CFP: 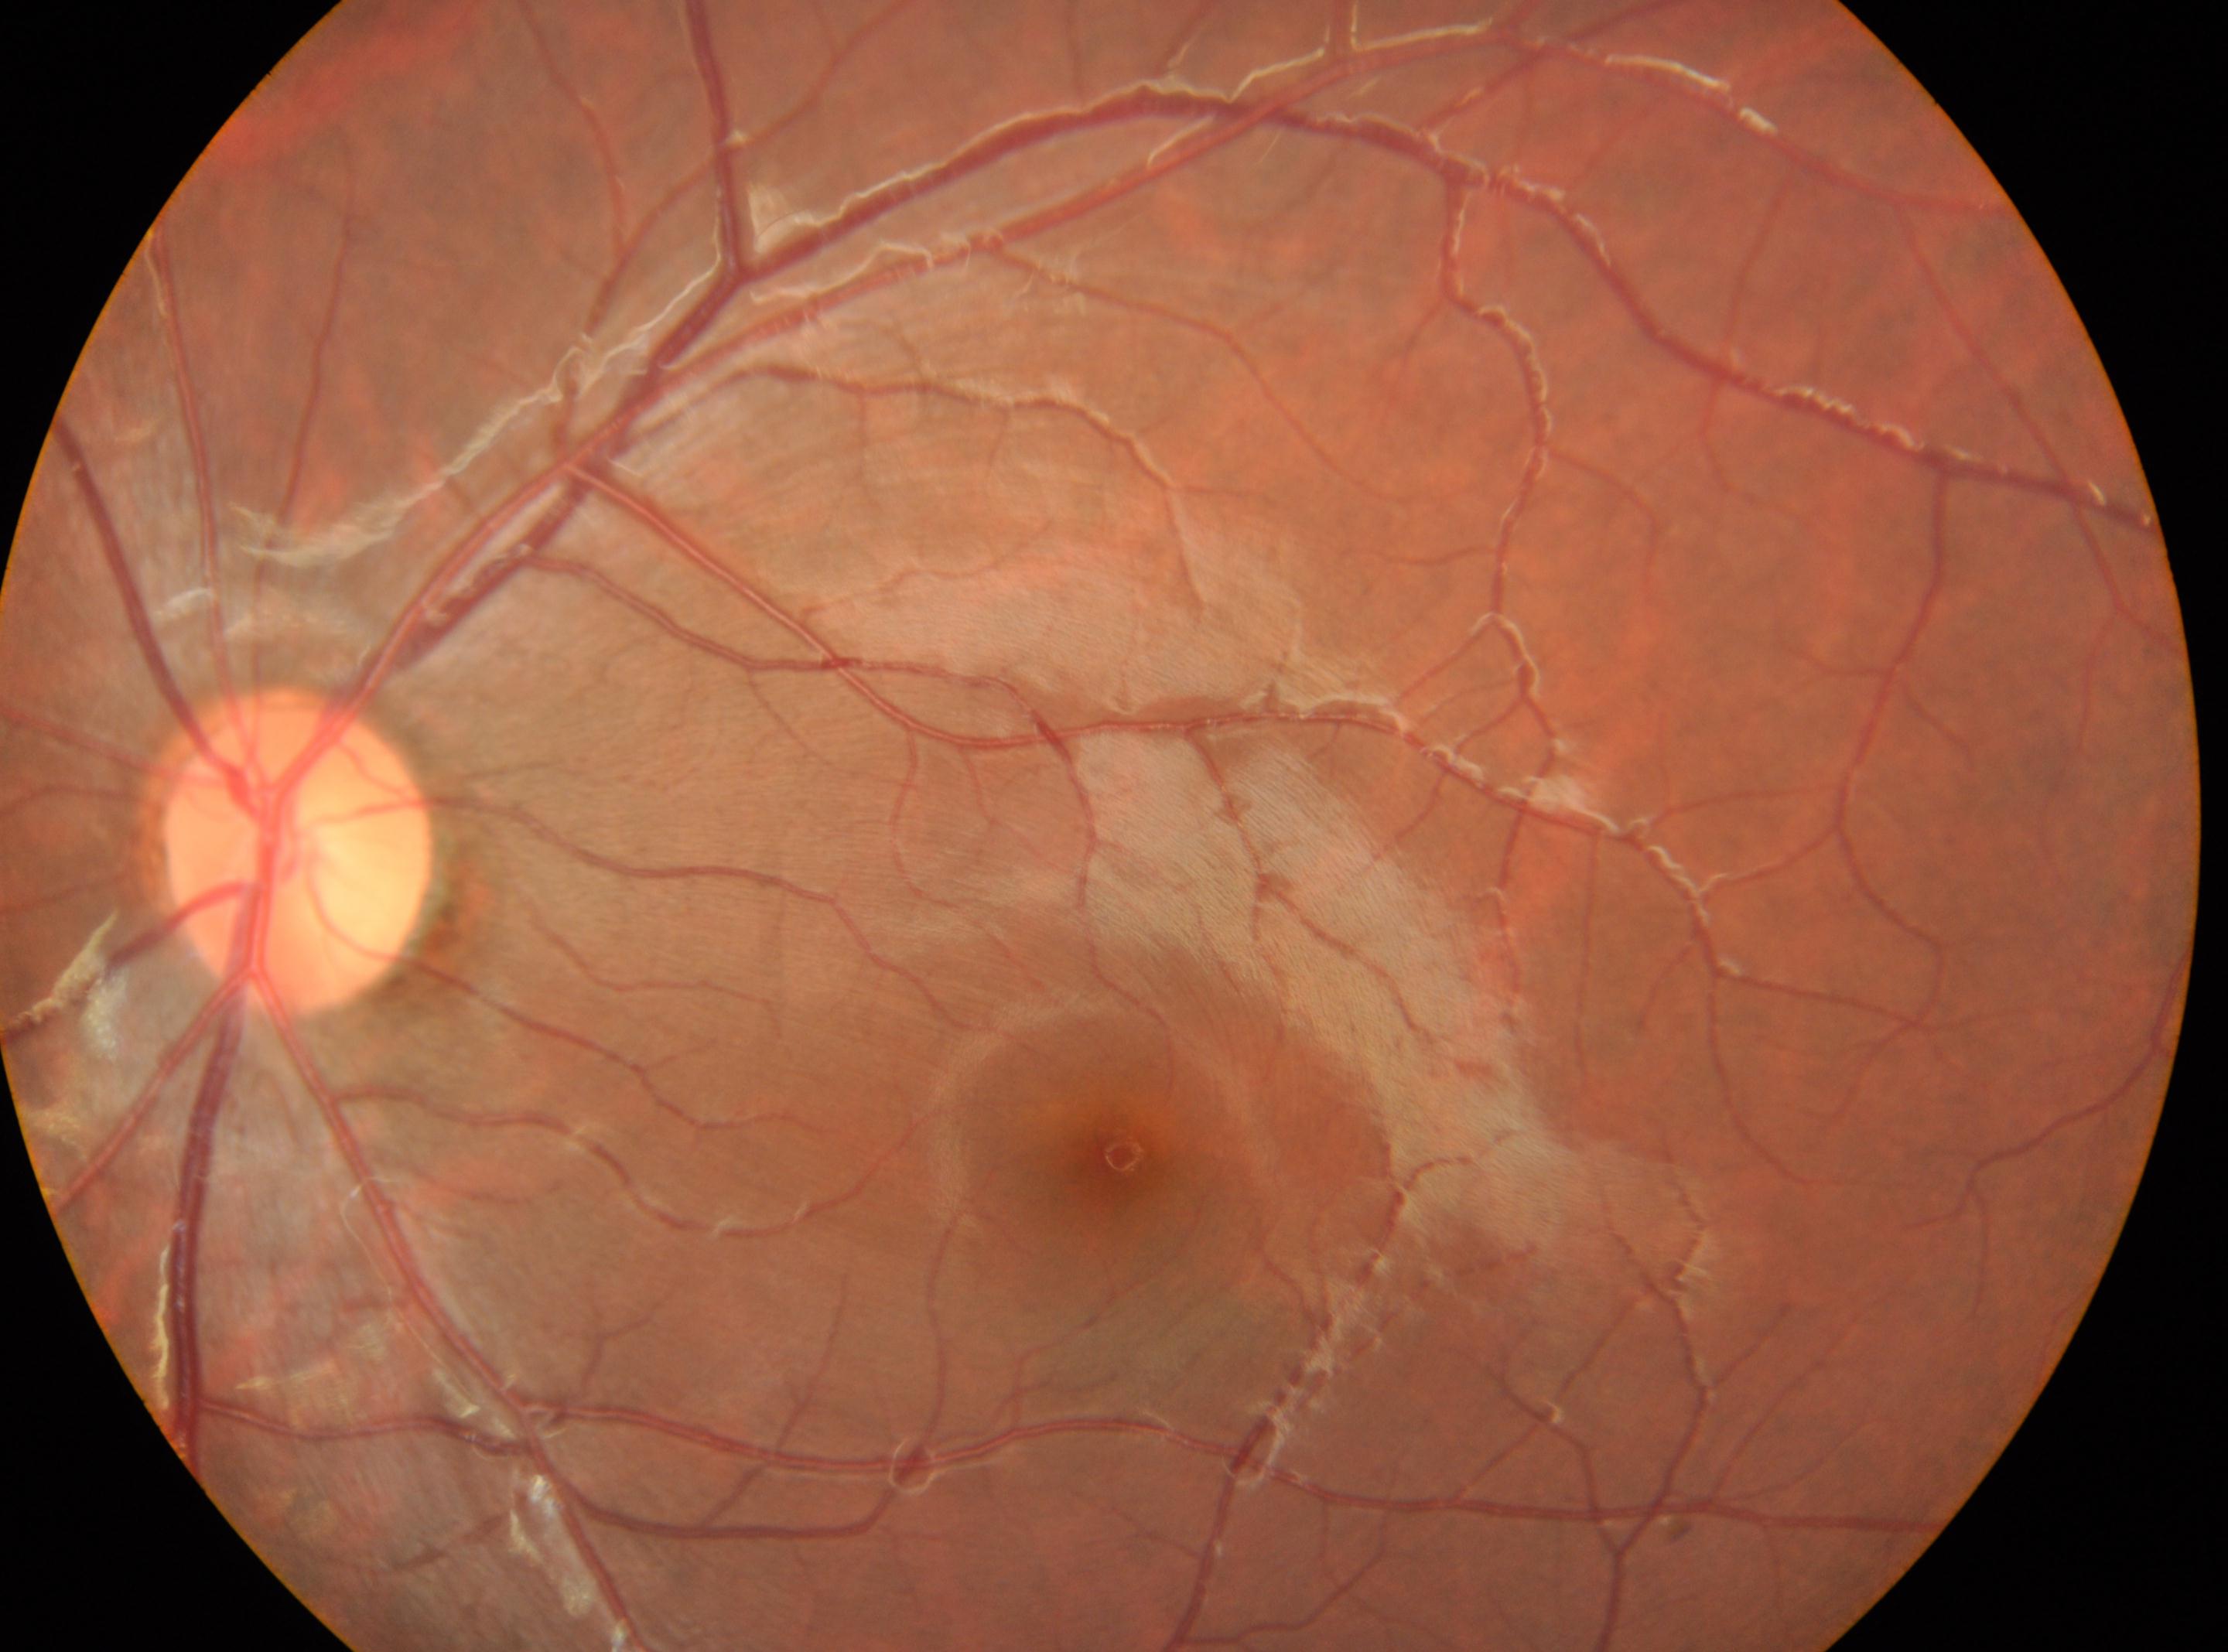

OS
diabetic retinopathy grade@0
foveal center@(x=1119, y=1154)
optic nerve head@(x=297, y=862)